45° FOV — 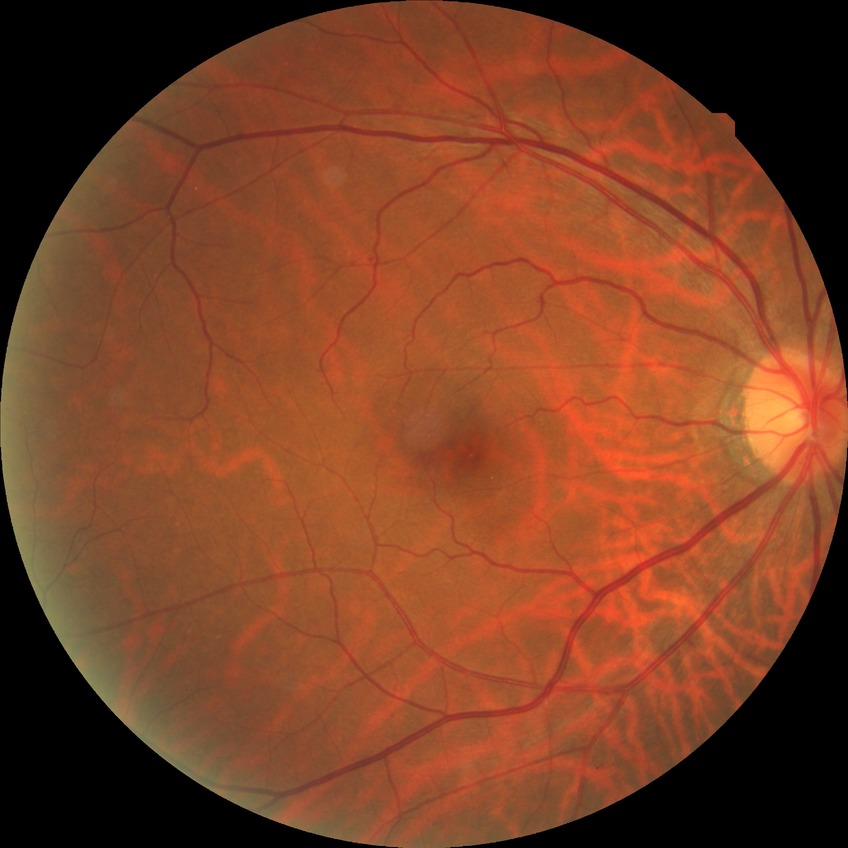
Modified Davis grade is NDR.
No apparent diabetic retinopathy.